Color fundus photograph — 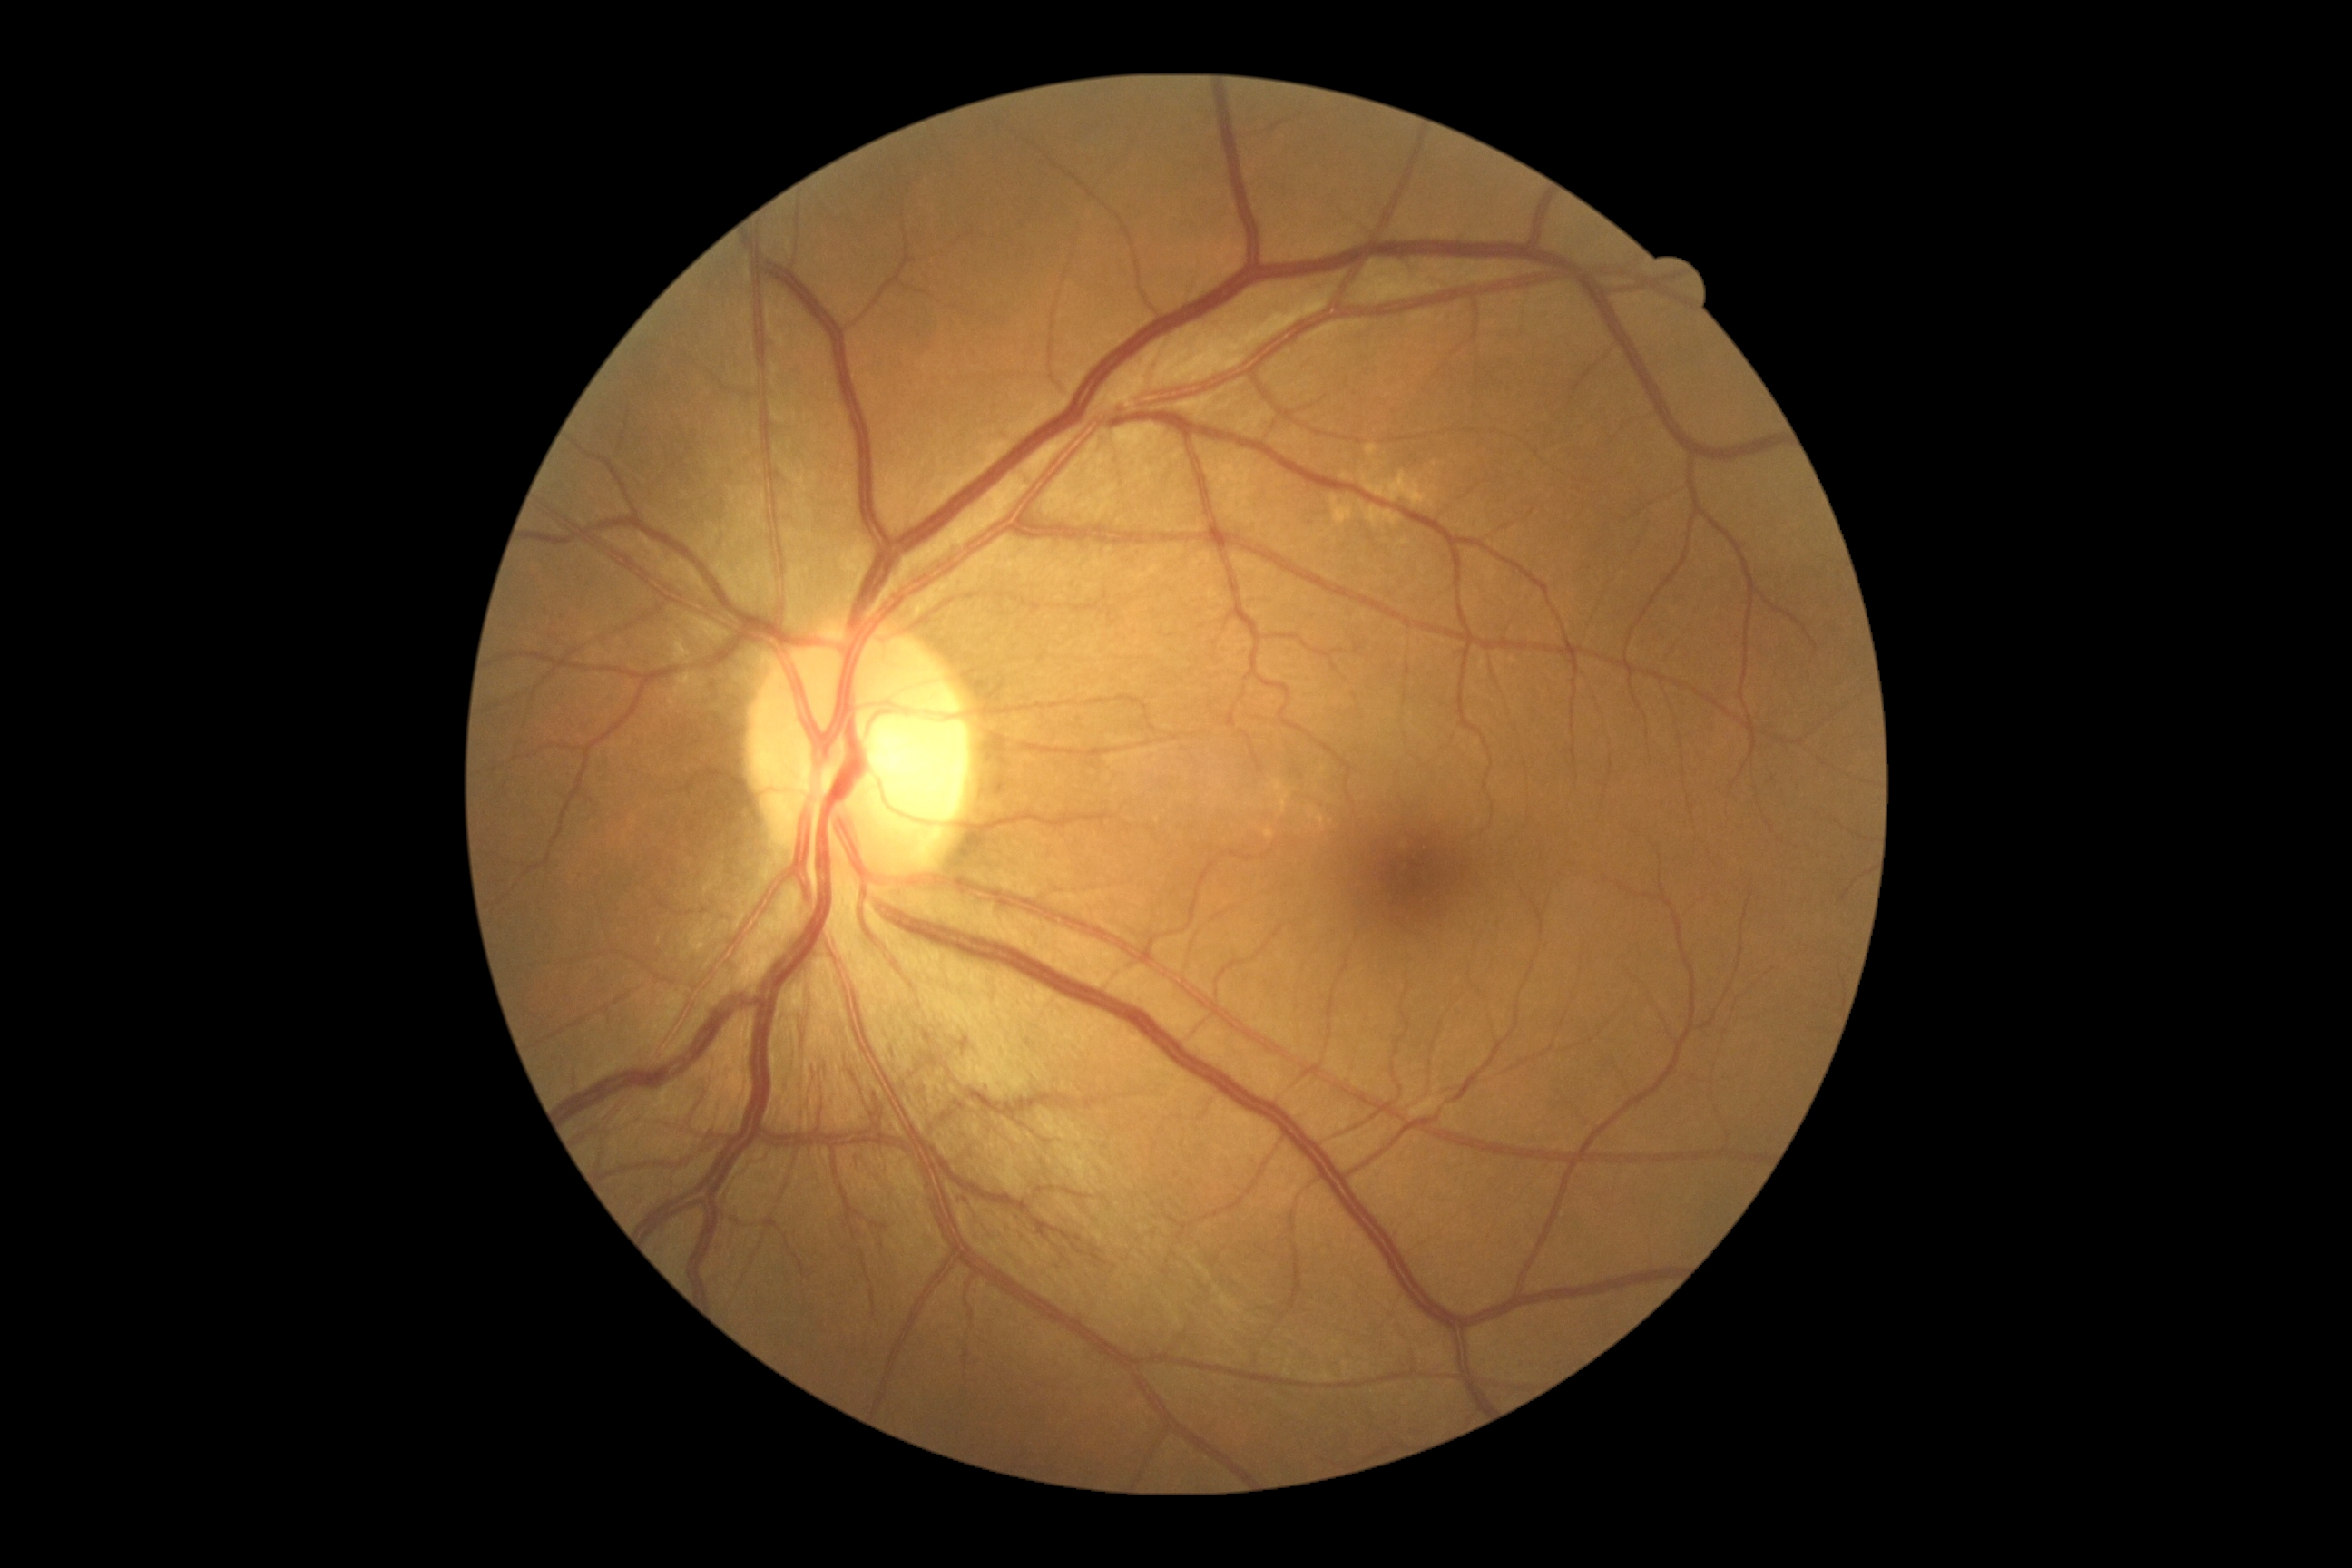
diabetic retinopathy (DR)=3.